1932 by 1932 pixels. Color fundus image. 45-degree field of view.
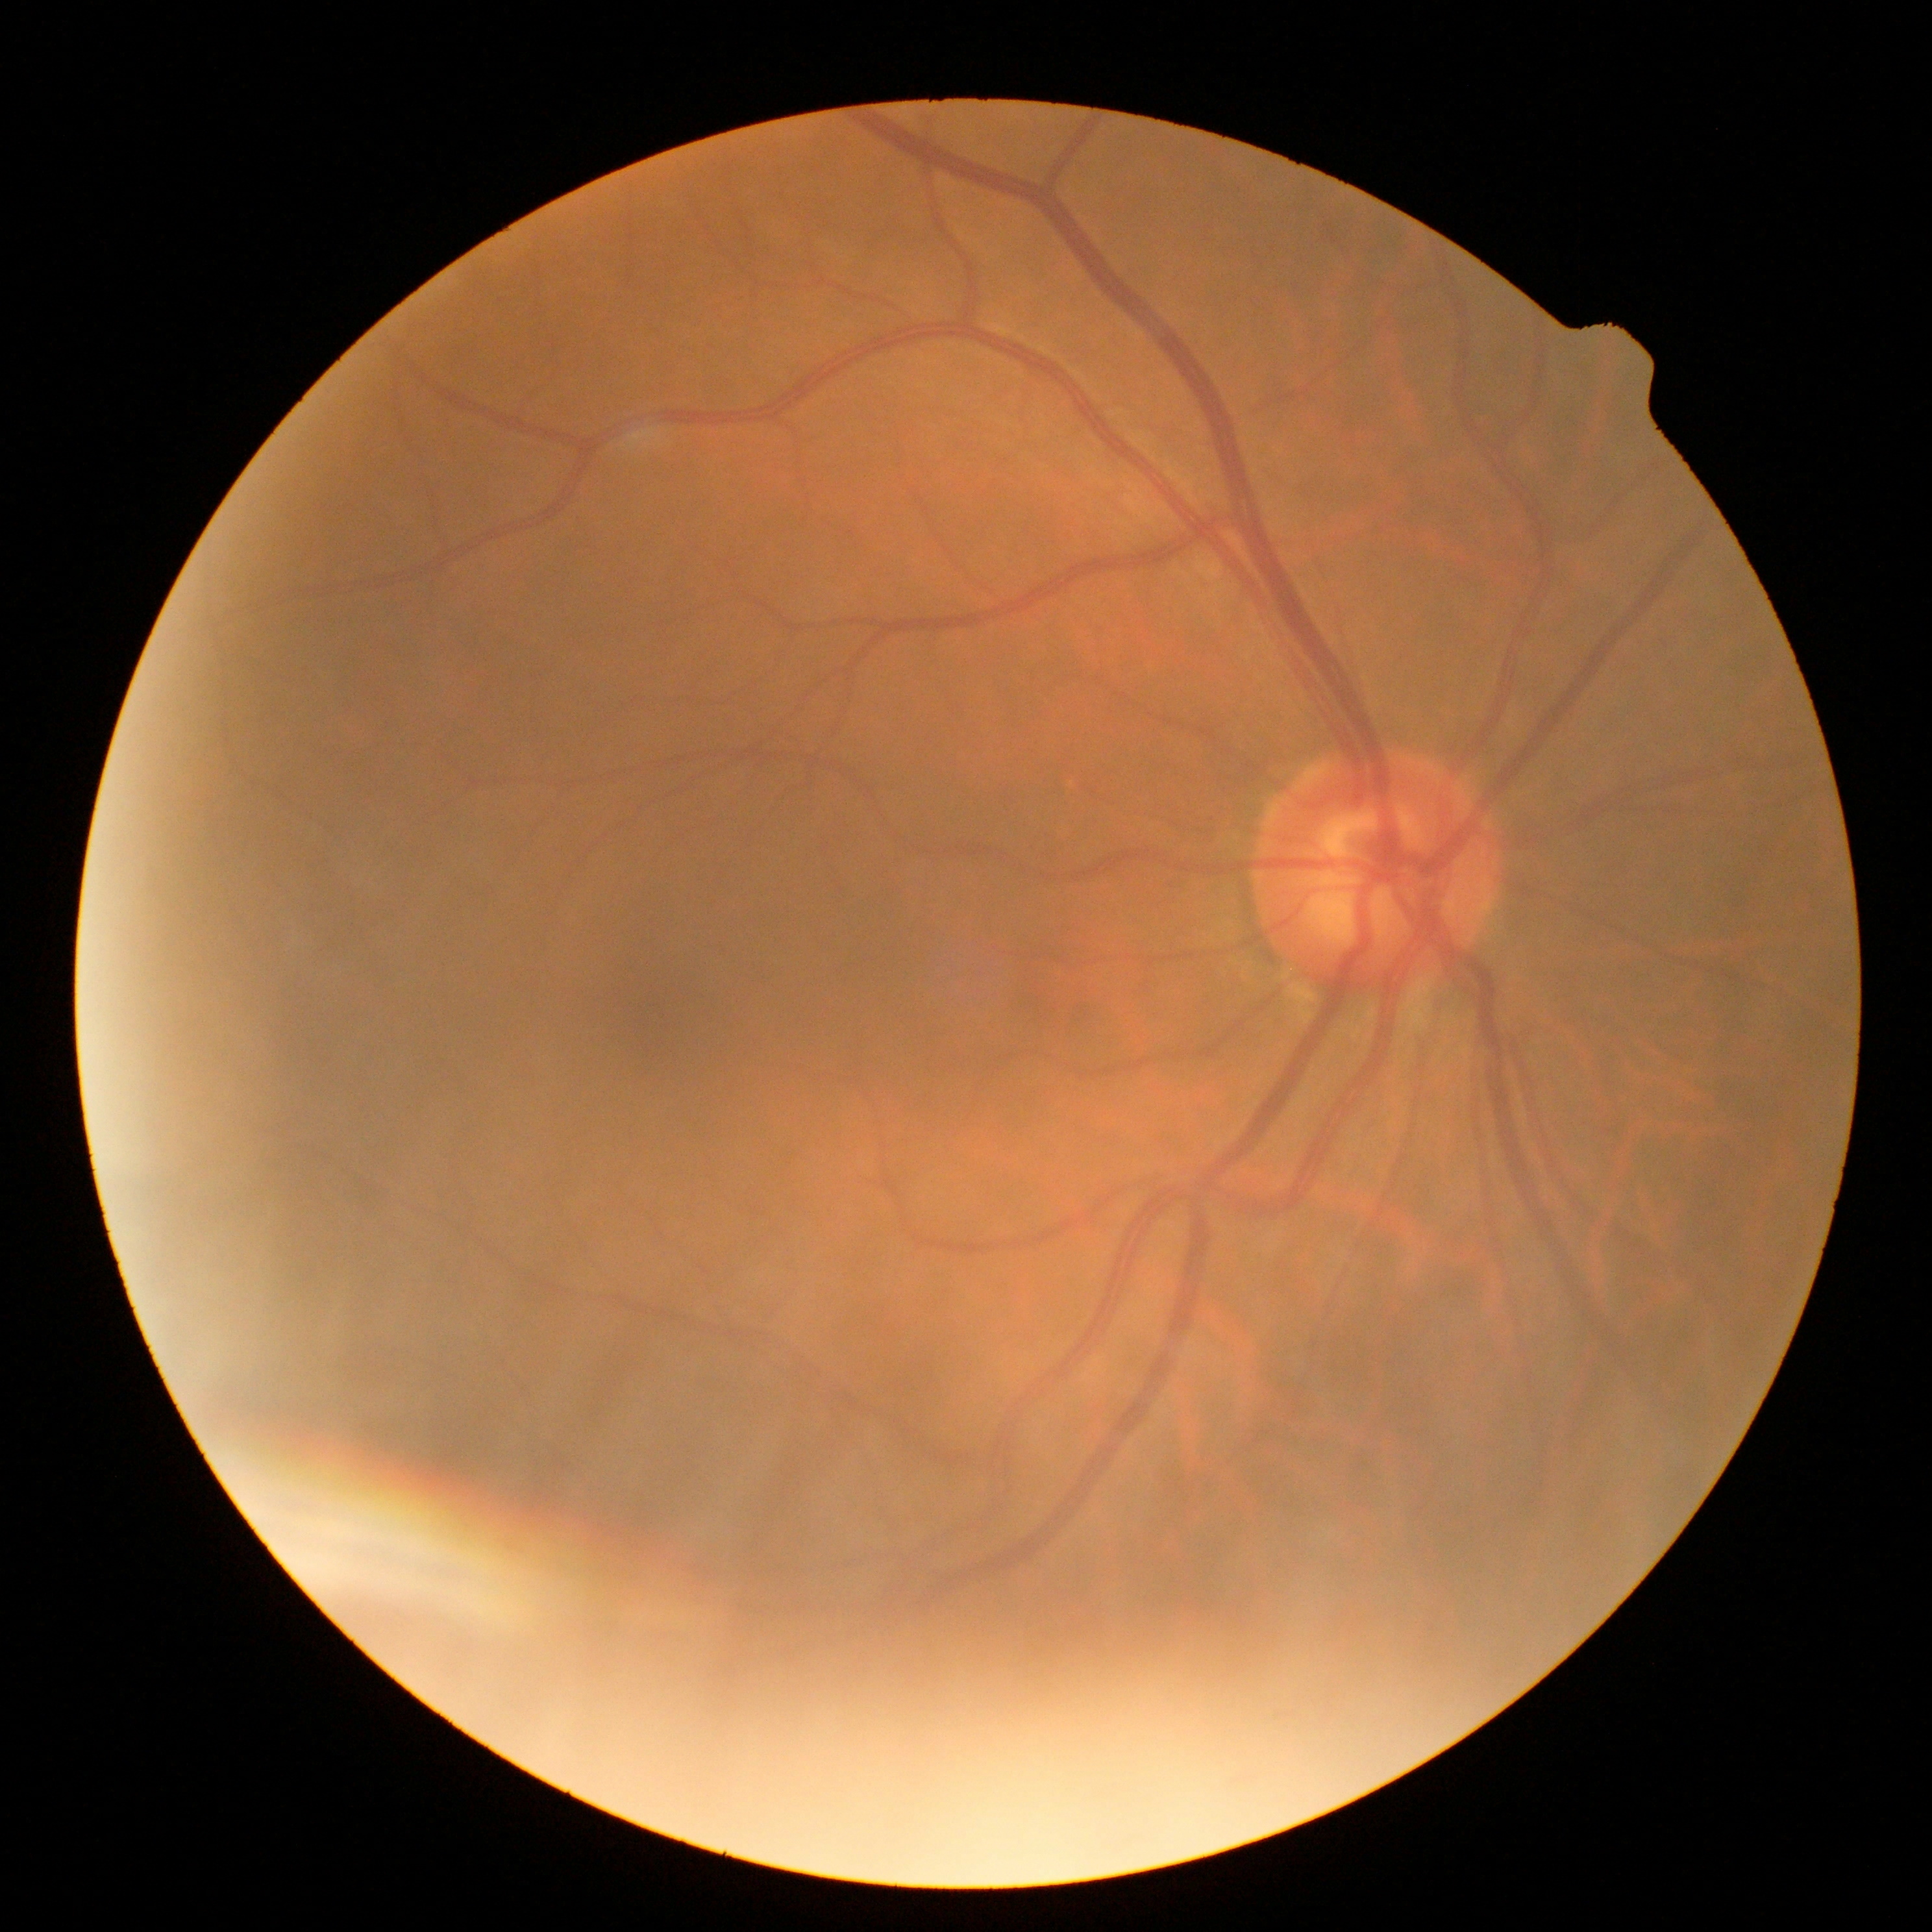 No diabetic retinal disease findings. Diabetic retinopathy severity: grade 0 (no apparent retinopathy).